848x848px, nonmydriatic fundus photograph, NIDEK AFC-230 fundus camera, Davis DR grading, FOV: 45 degrees:
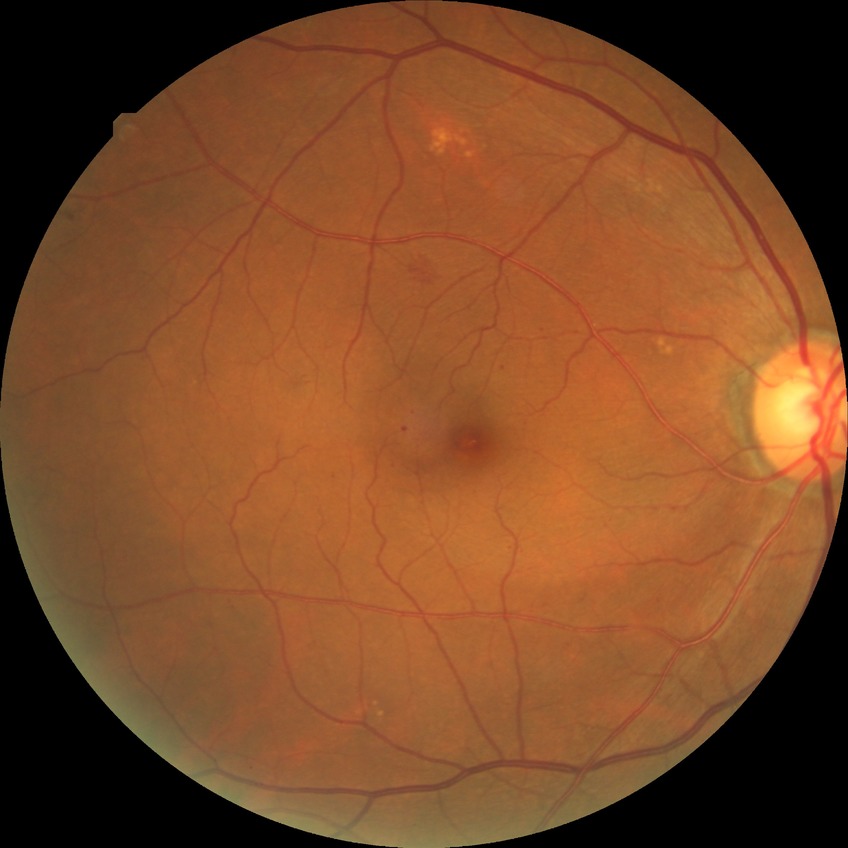
{
  "davis_grade": "SDR",
  "proliferative_class": "non-proliferative diabetic retinopathy"
}